Acquired on the Clarity RetCam 3 · pediatric retinal photograph (wide-field):
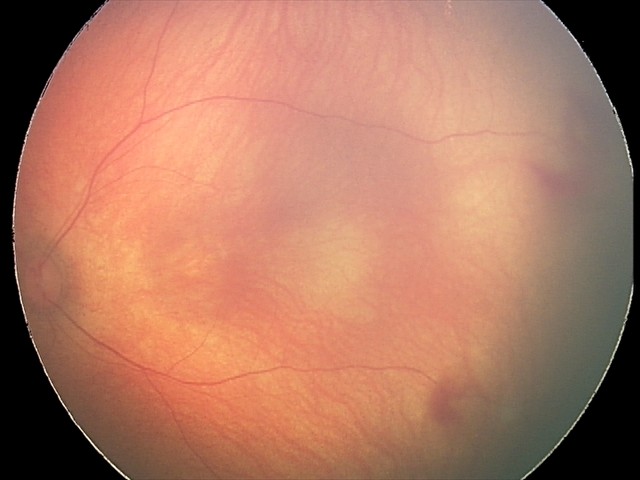

From an examination with diagnosis of retinal hemorrhages.